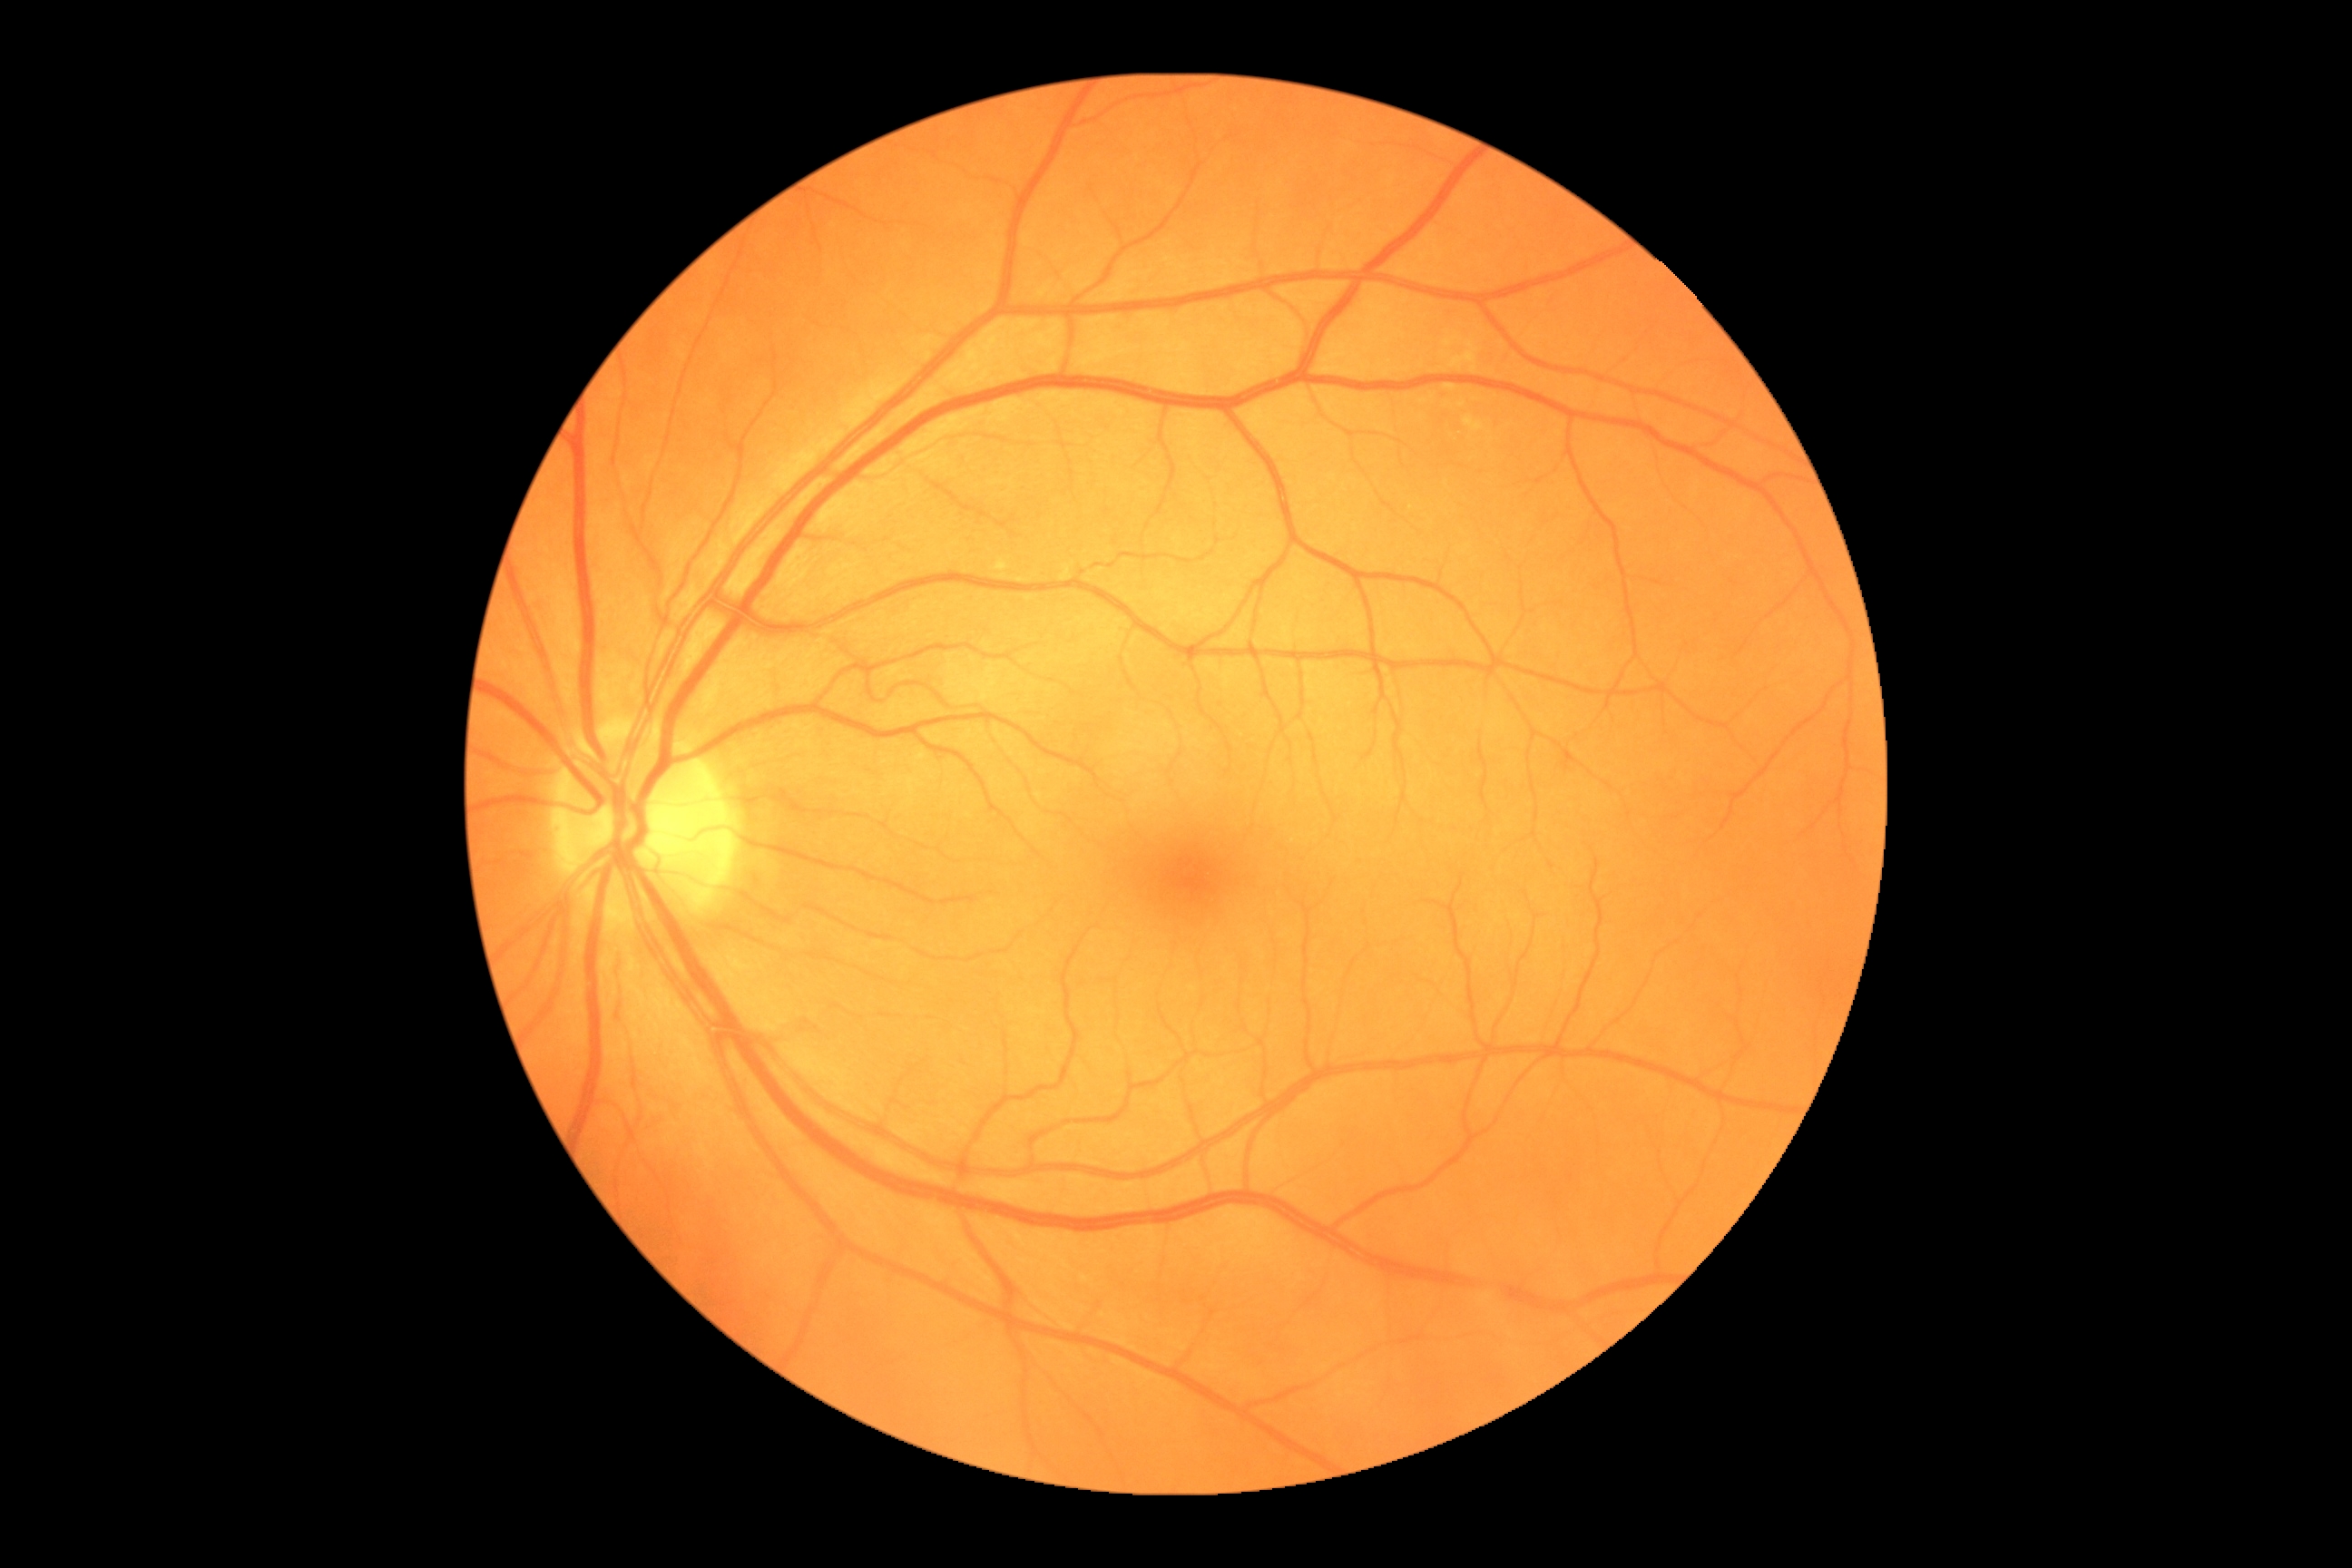

DR stage is no apparent retinopathy (grade 0).